Infant wide-field retinal image
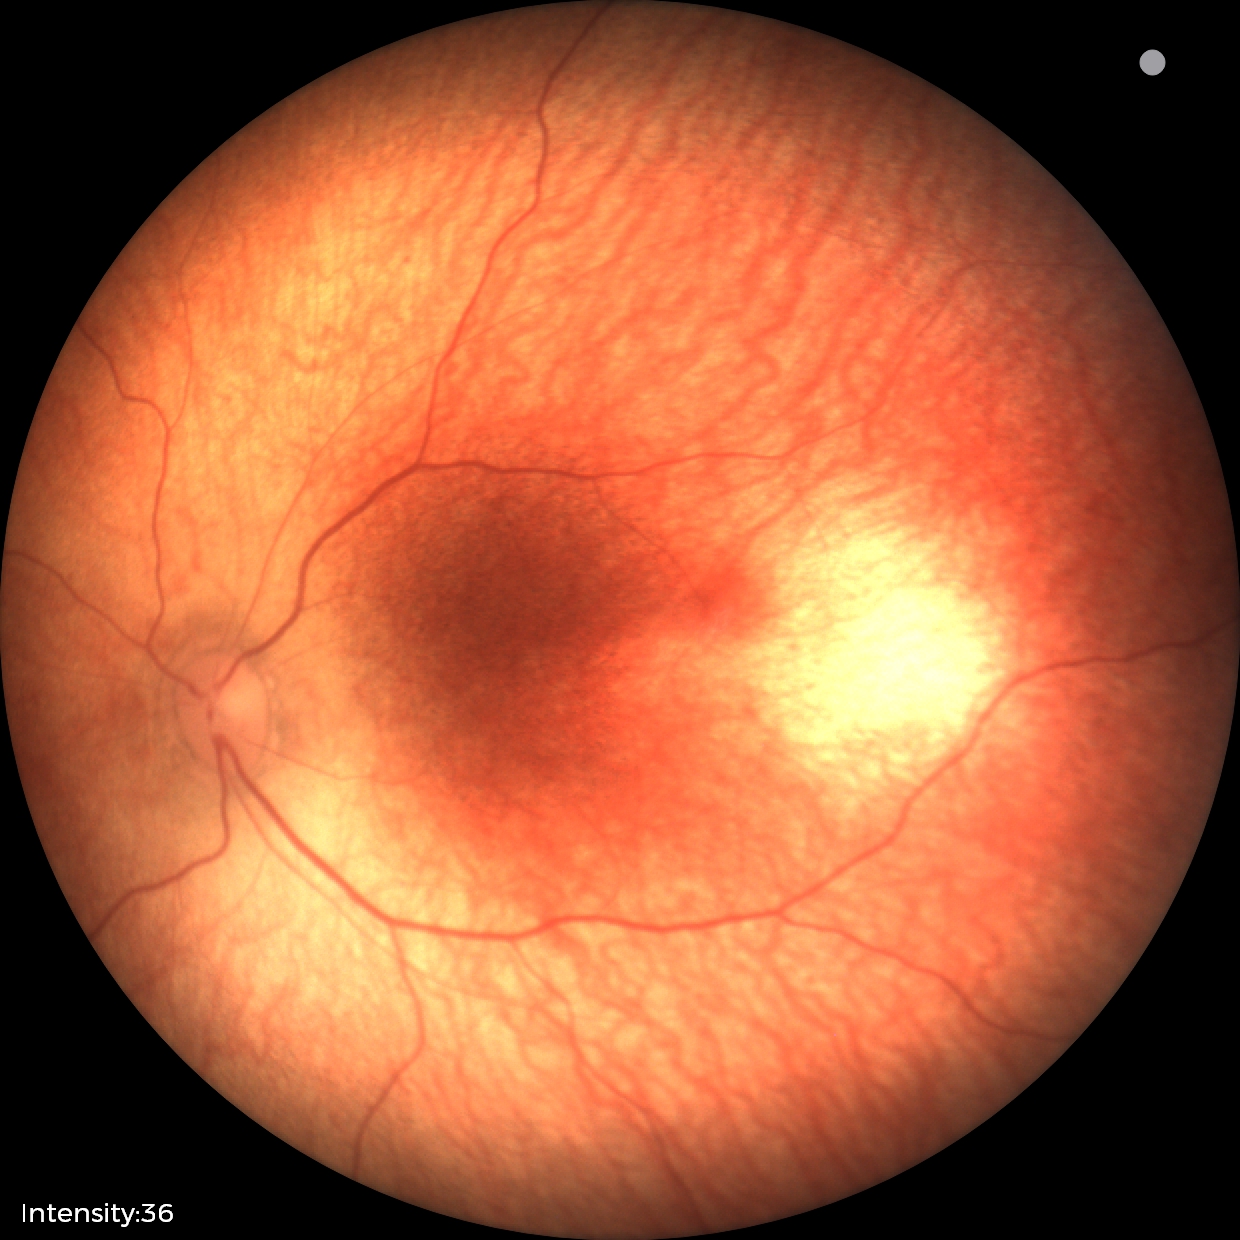 Normal screening examination.